Wide-field contact fundus photograph of an infant
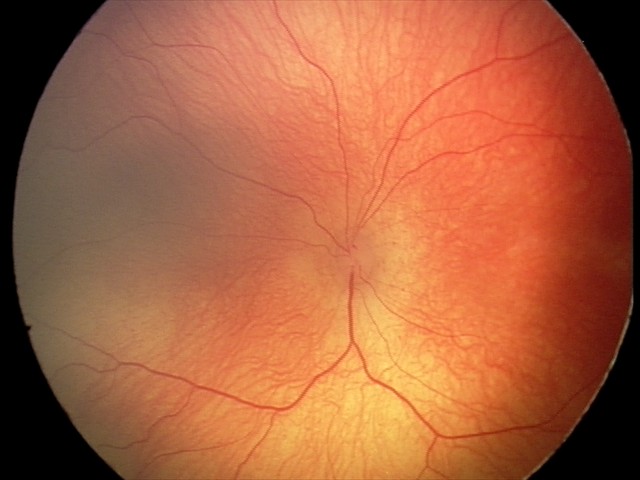 Diagnosis from this screening exam: retinopathy of prematurity (ROP) stage 2. Plus disease absent.